1504 x 1000 pixels:
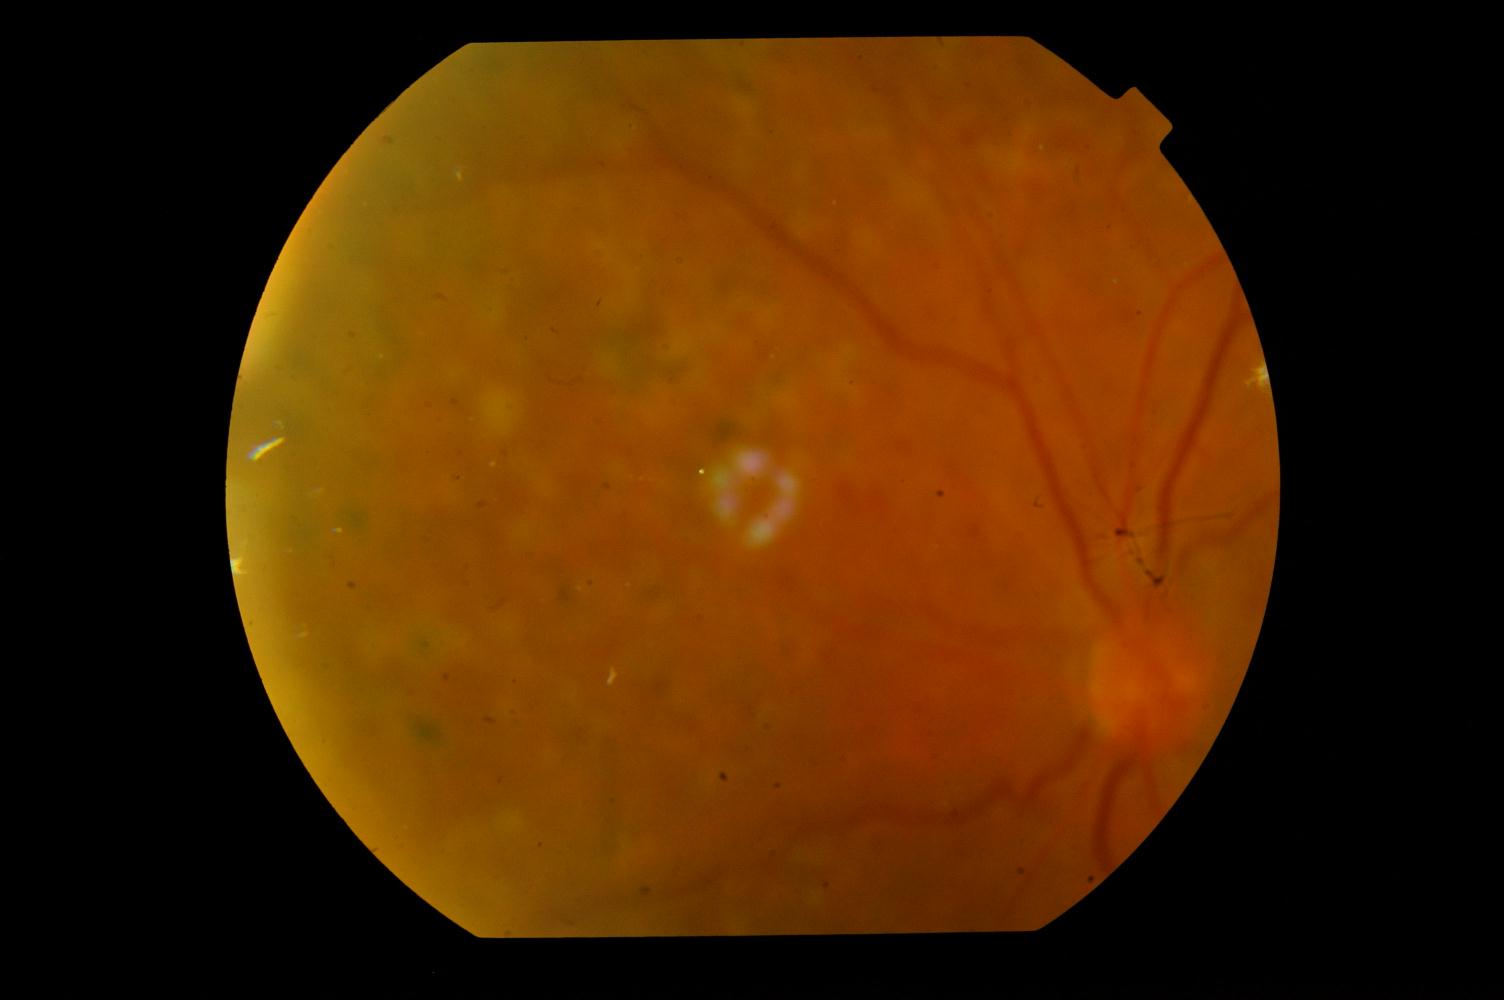
Pathology:
- diabetic retinopathy